Image size 2352x1568; 45-degree field of view — 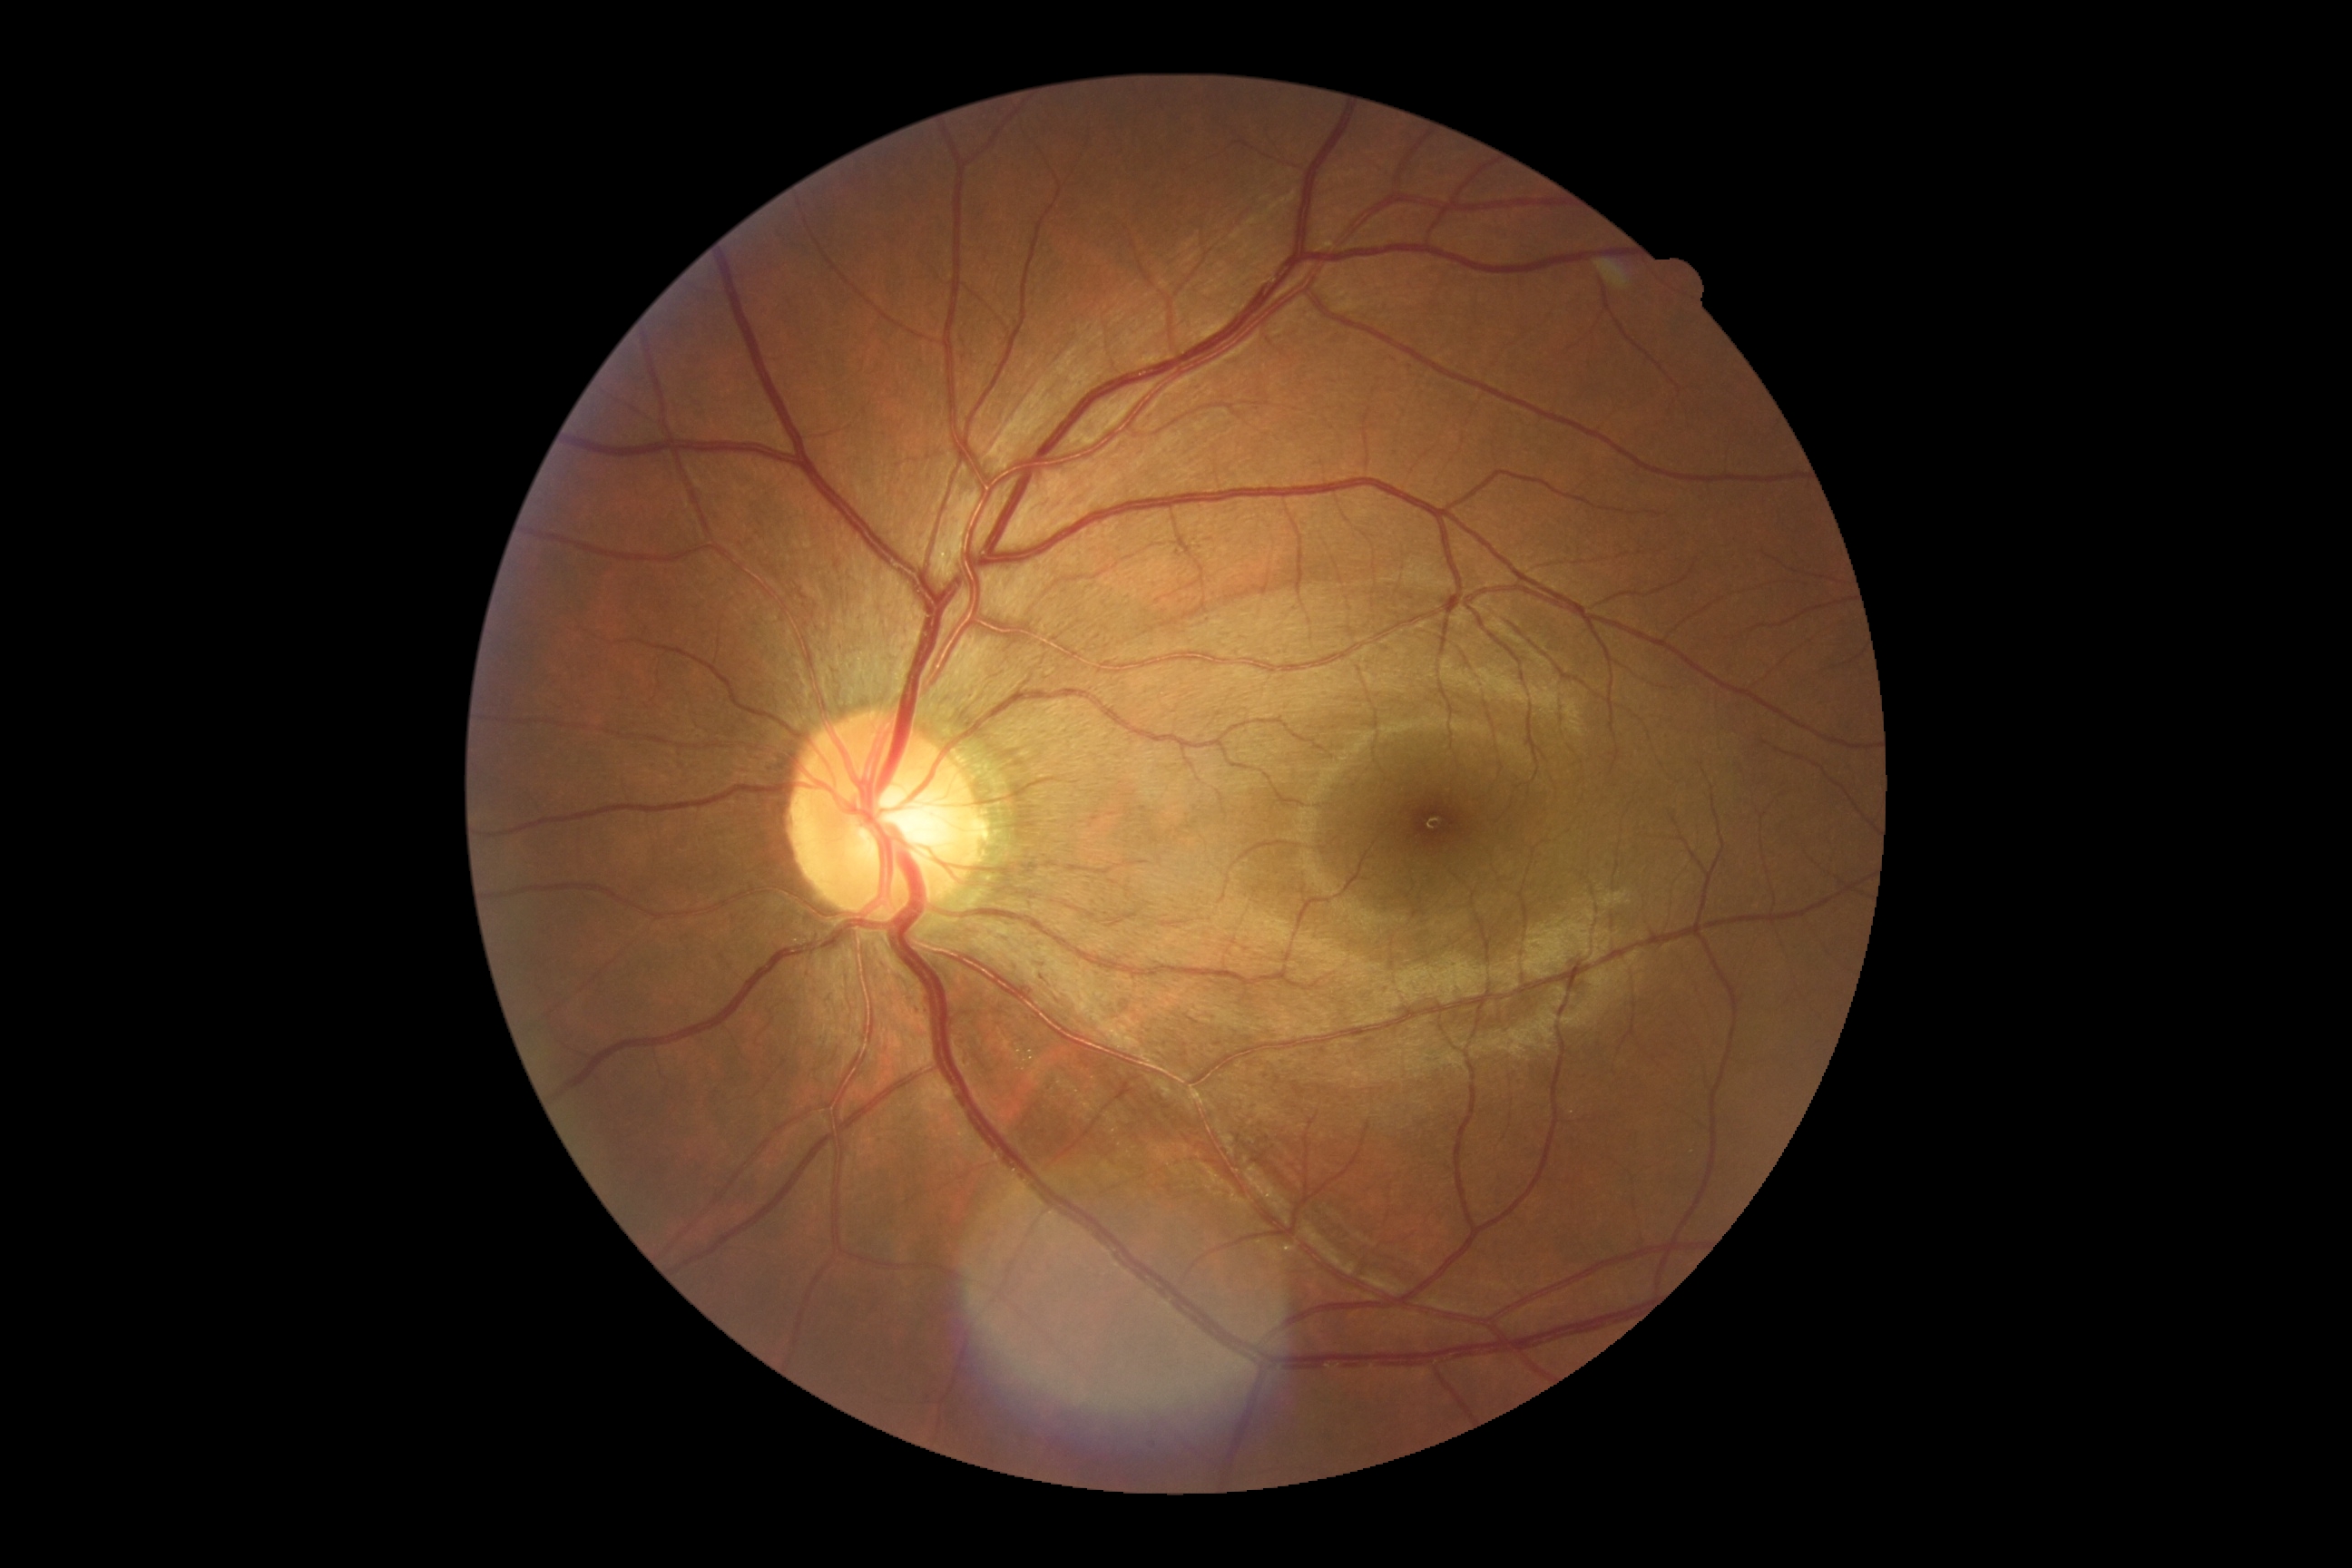 {"dr_grade": "0/4 — no visible signs of diabetic retinopathy"}